FOV: 45 degrees.
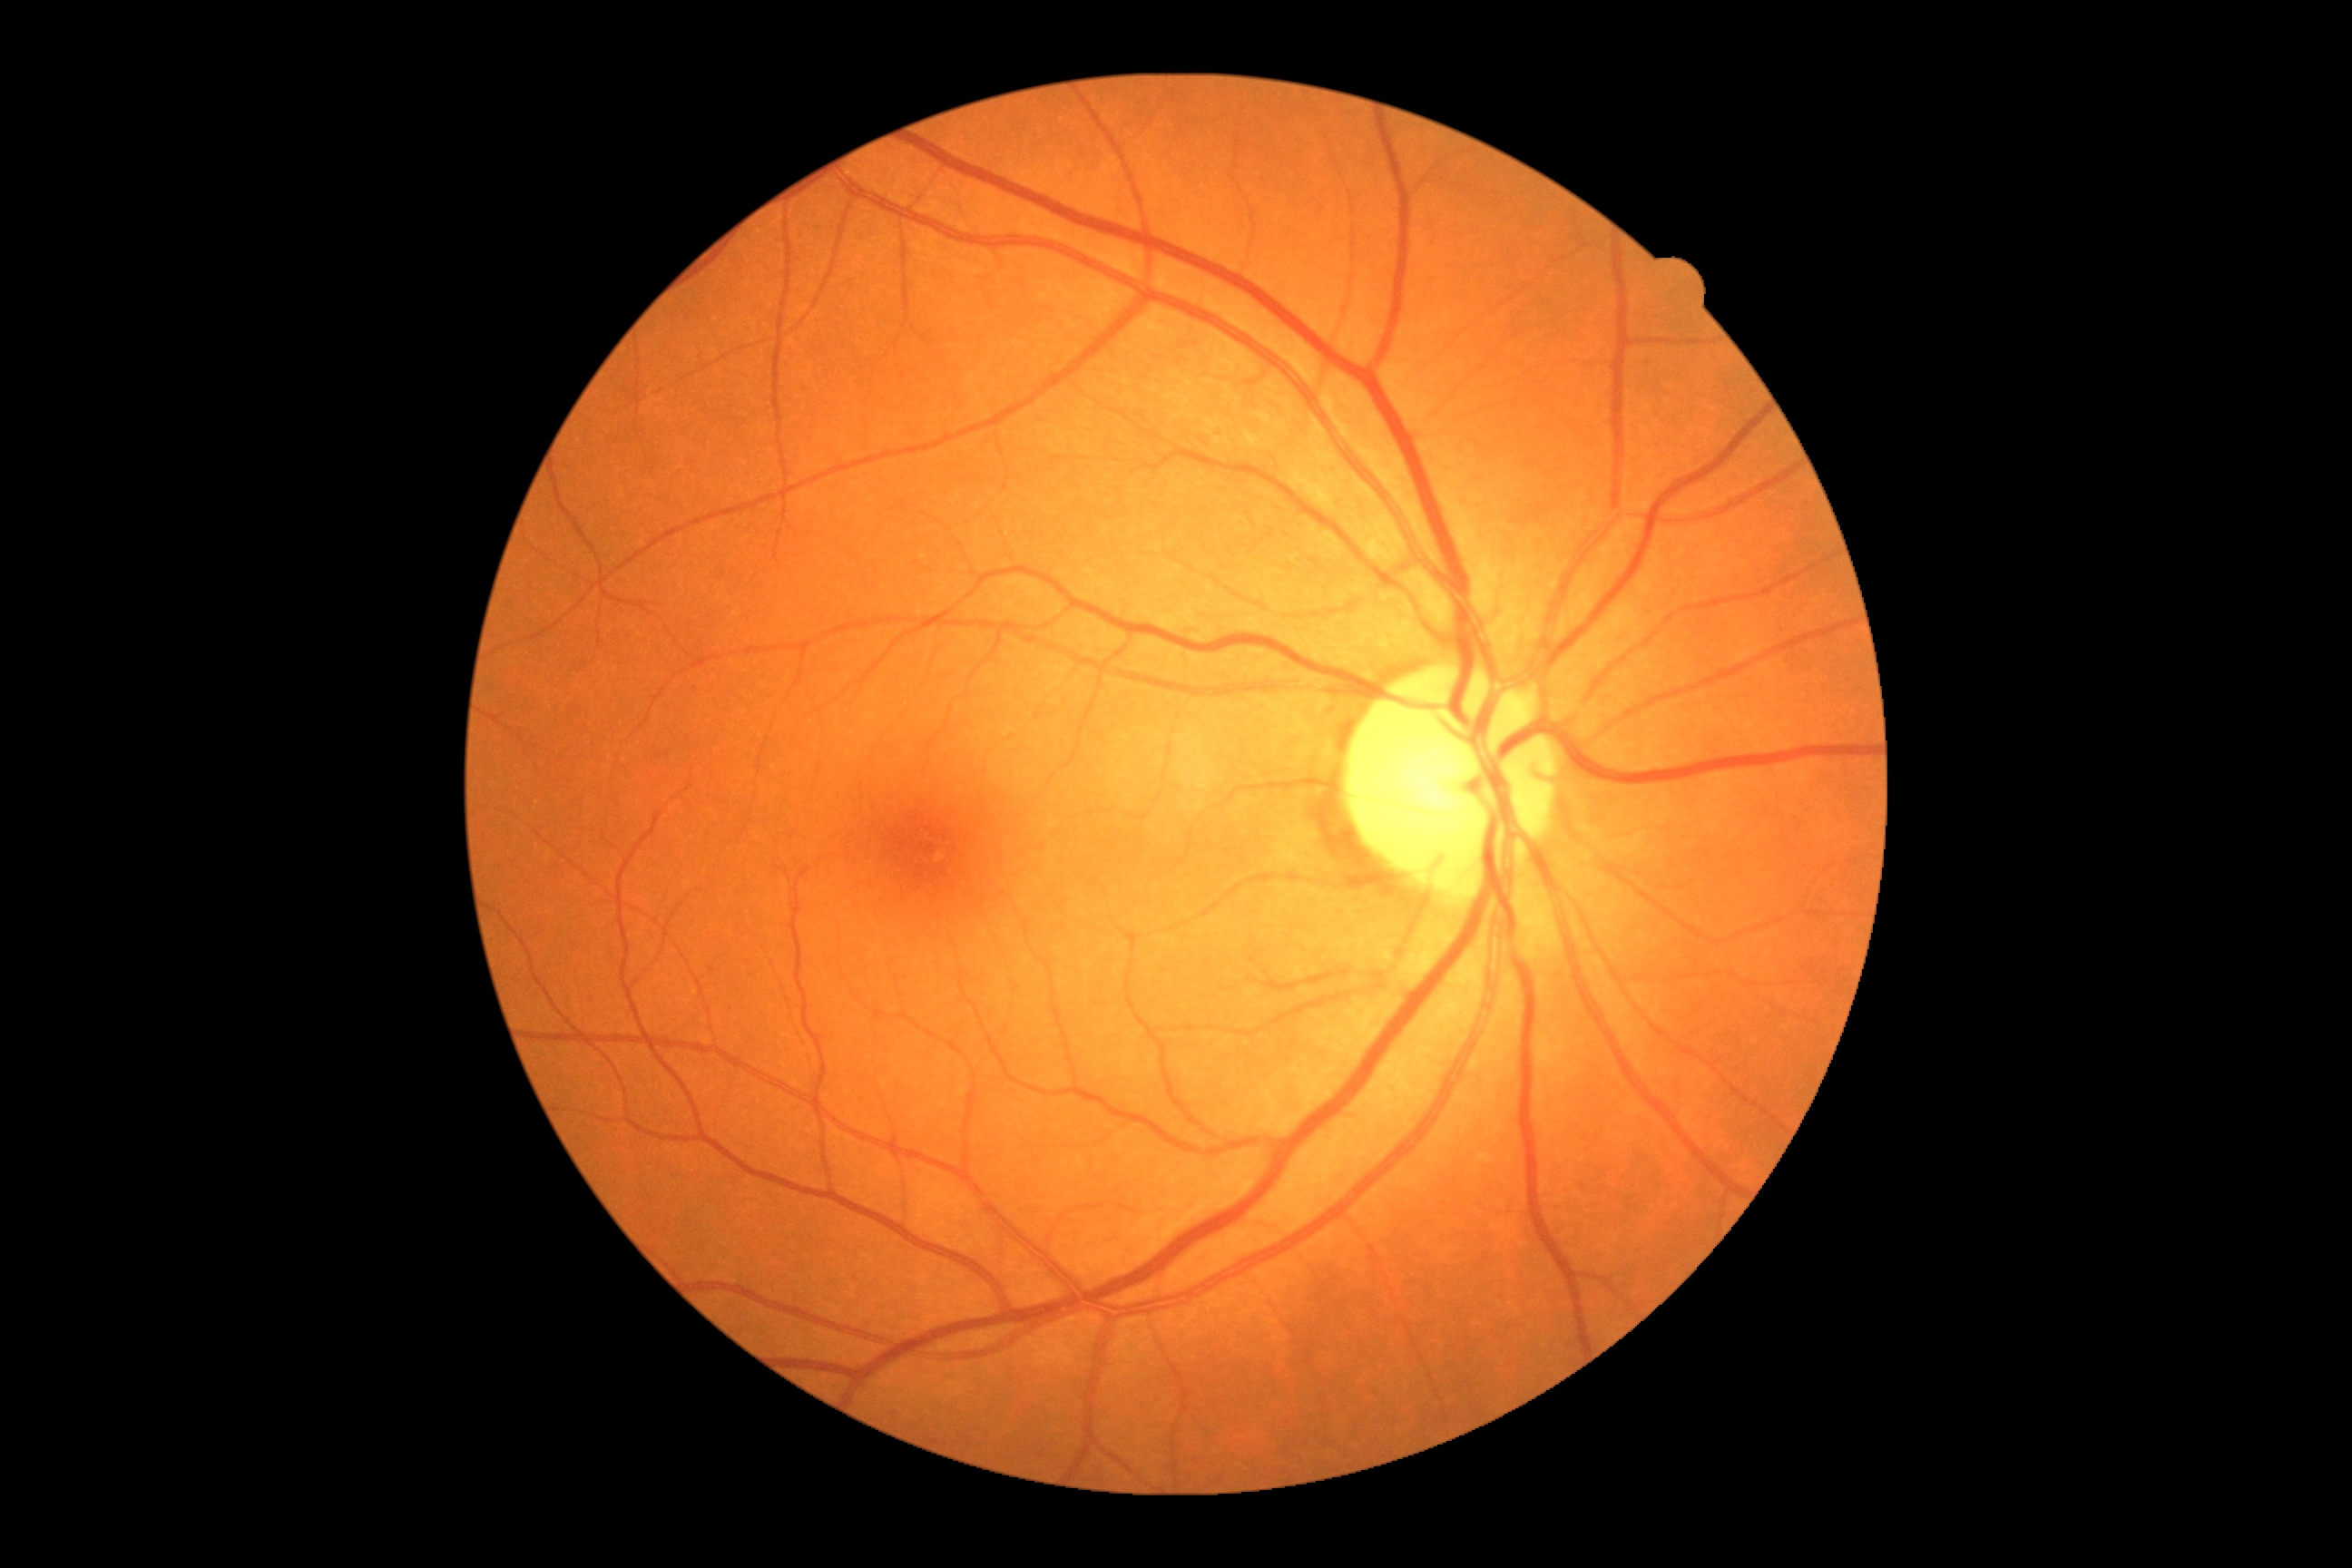
DR impression: no DR findings
DR: grade 0 (no apparent retinopathy) — no visible signs of diabetic retinopathy